Image size 640x480. Wide-field fundus image from infant ROP screening.
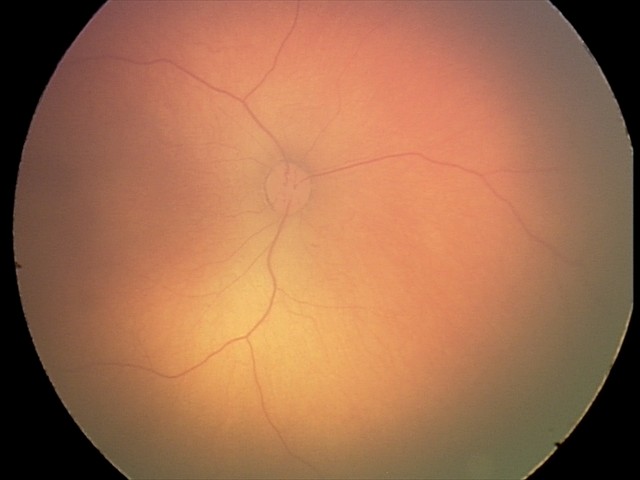
Screening examination with no abnormal retinal findings.